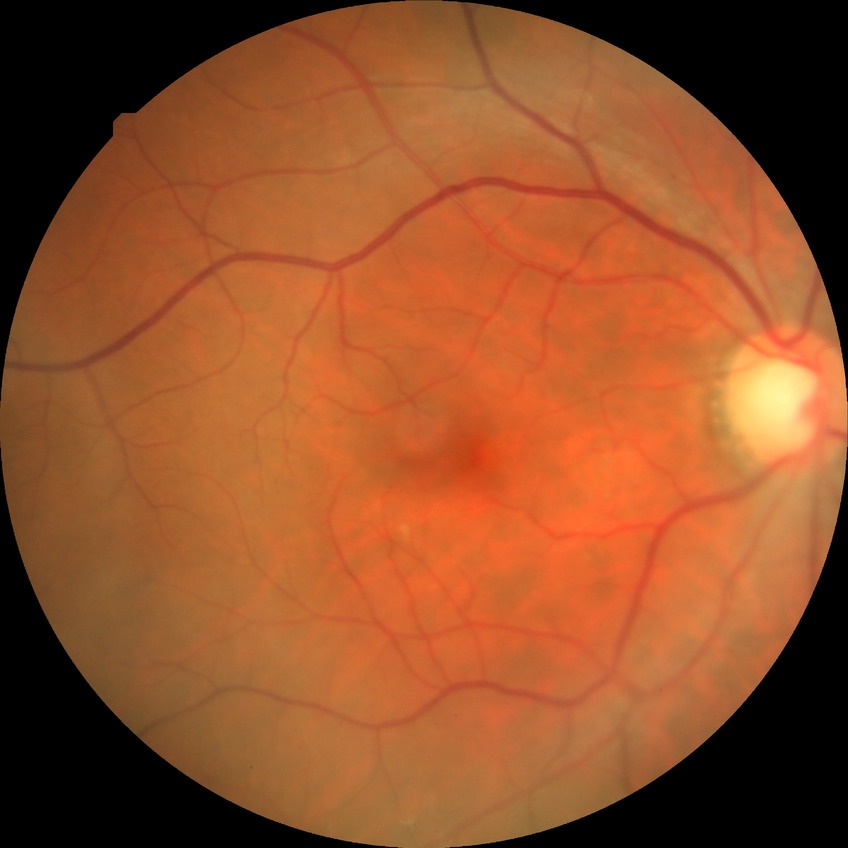

{
  "davis_grade": "no diabetic retinopathy (NDR)"
}